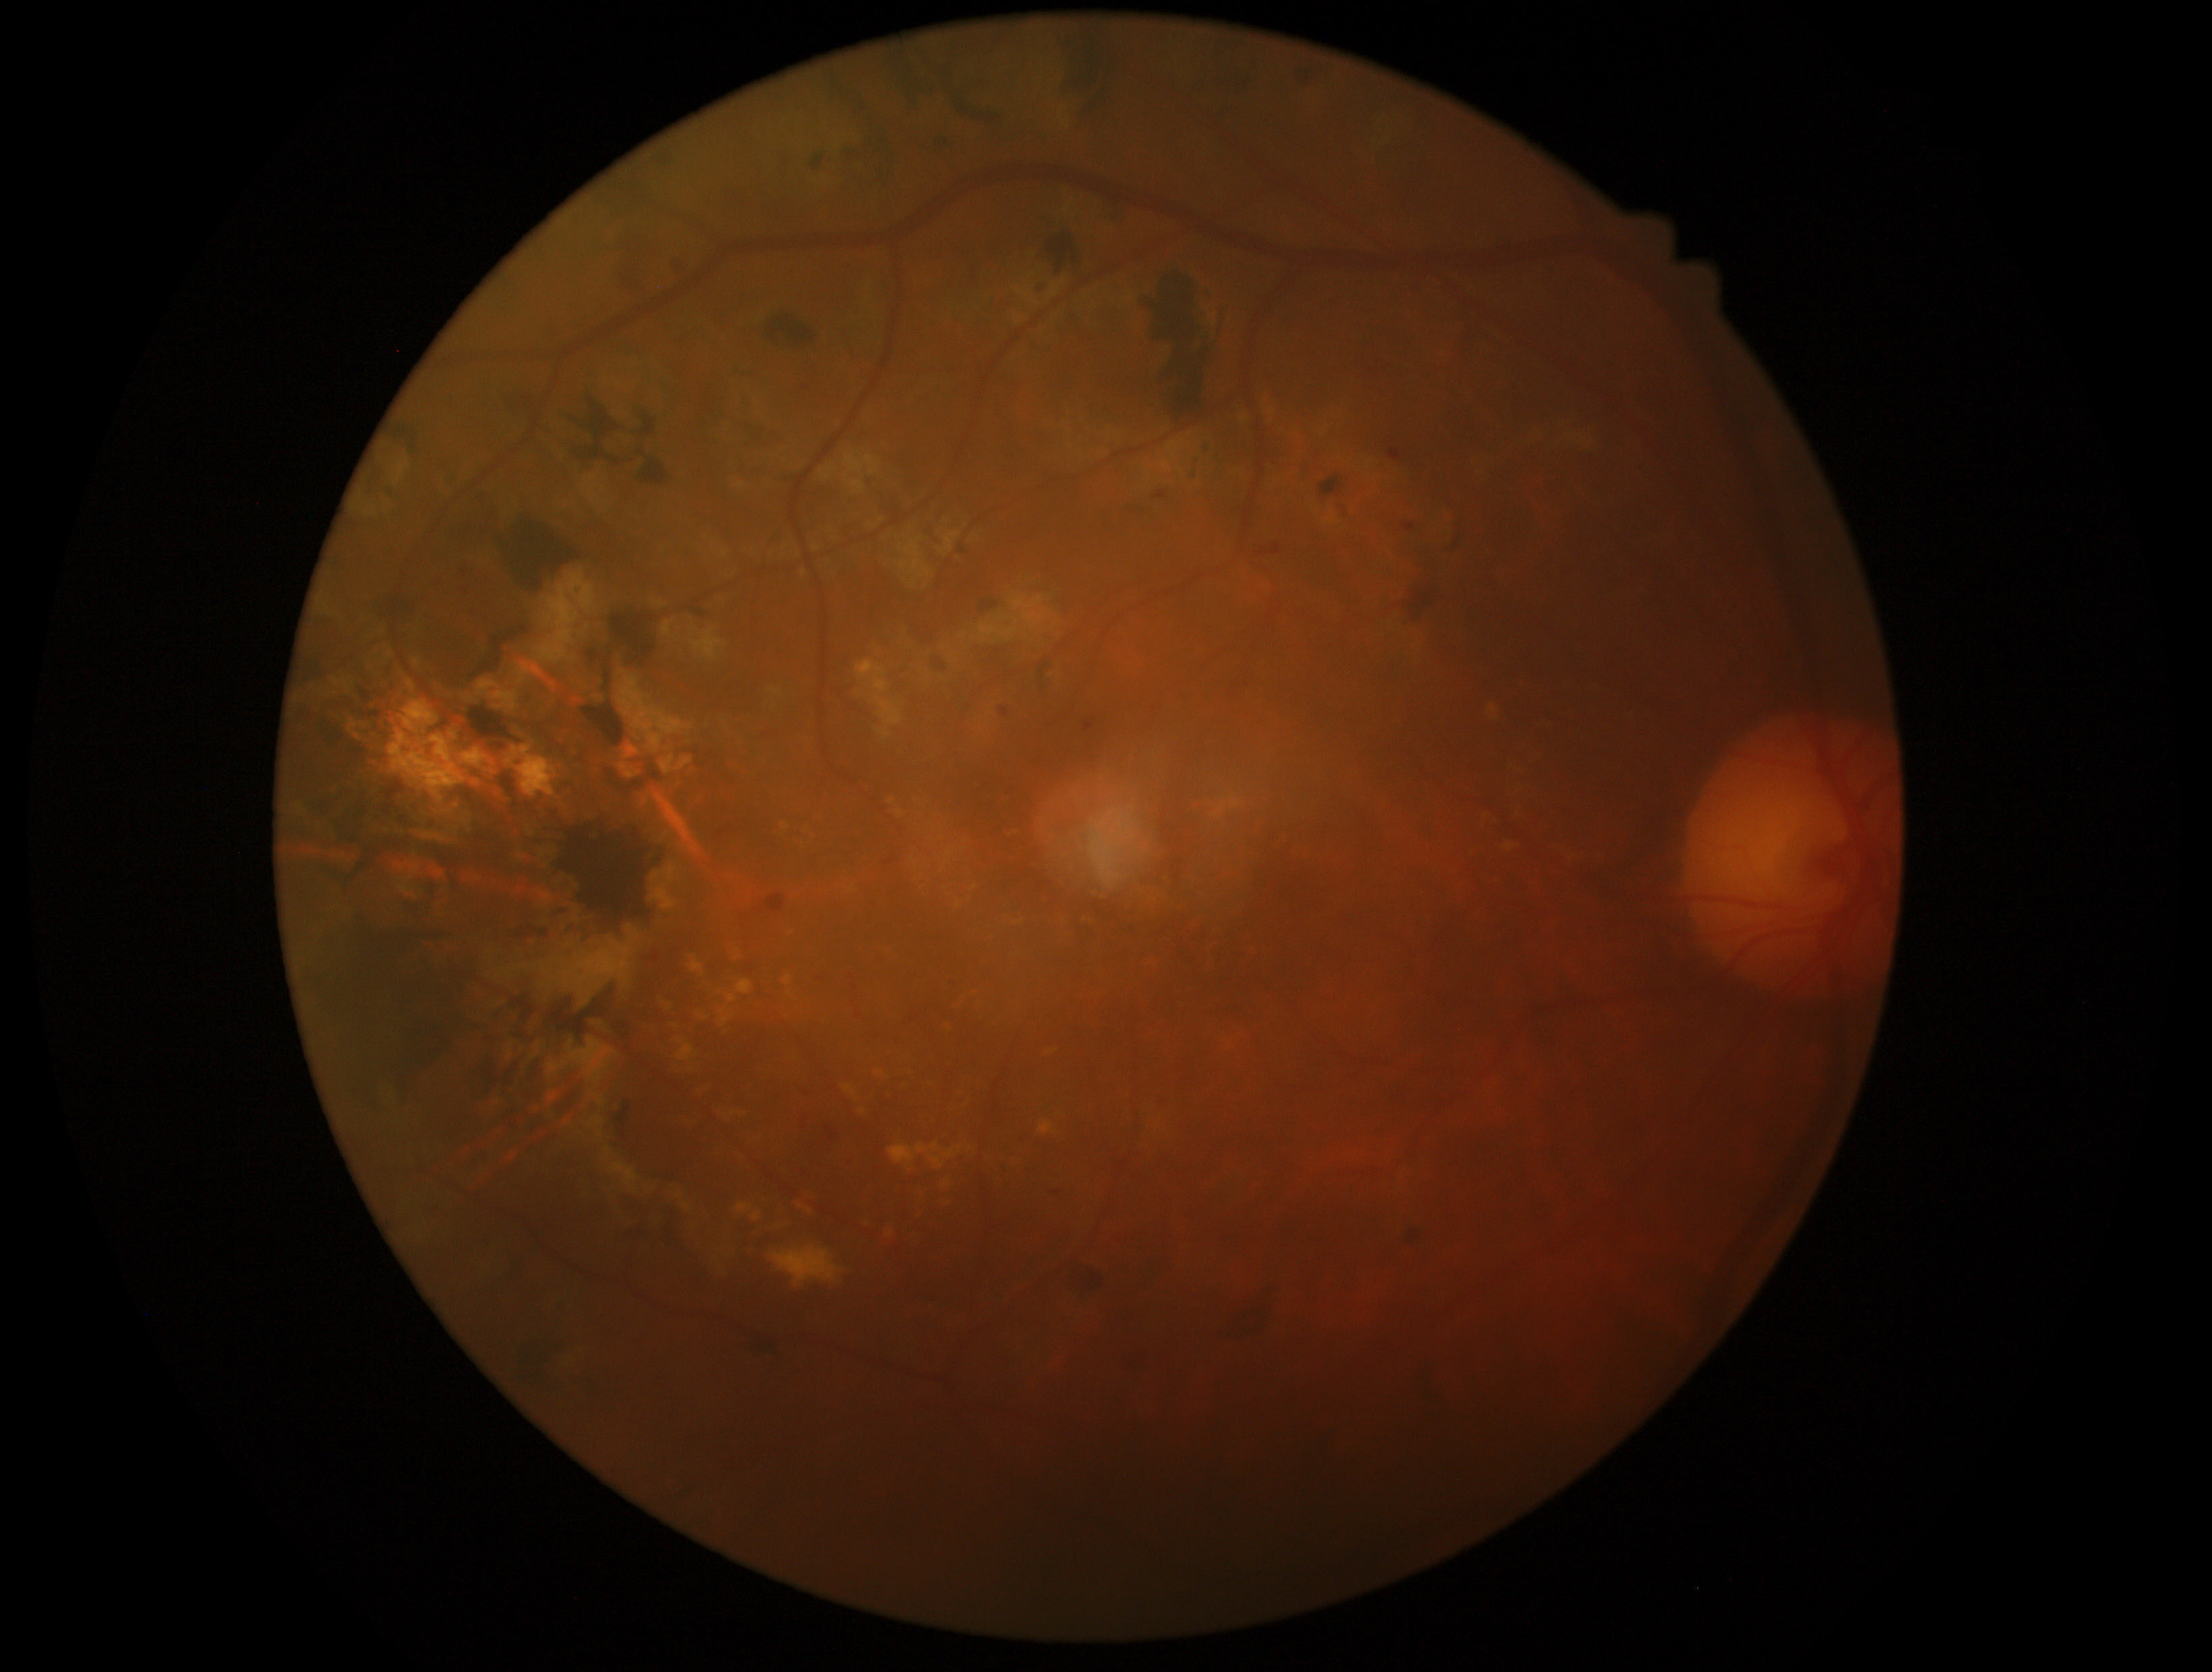
The retinopathy is classified as non-proliferative diabetic retinopathy. Diabetic retinopathy (DR): grade 2 (moderate NPDR).